2048x1536px.
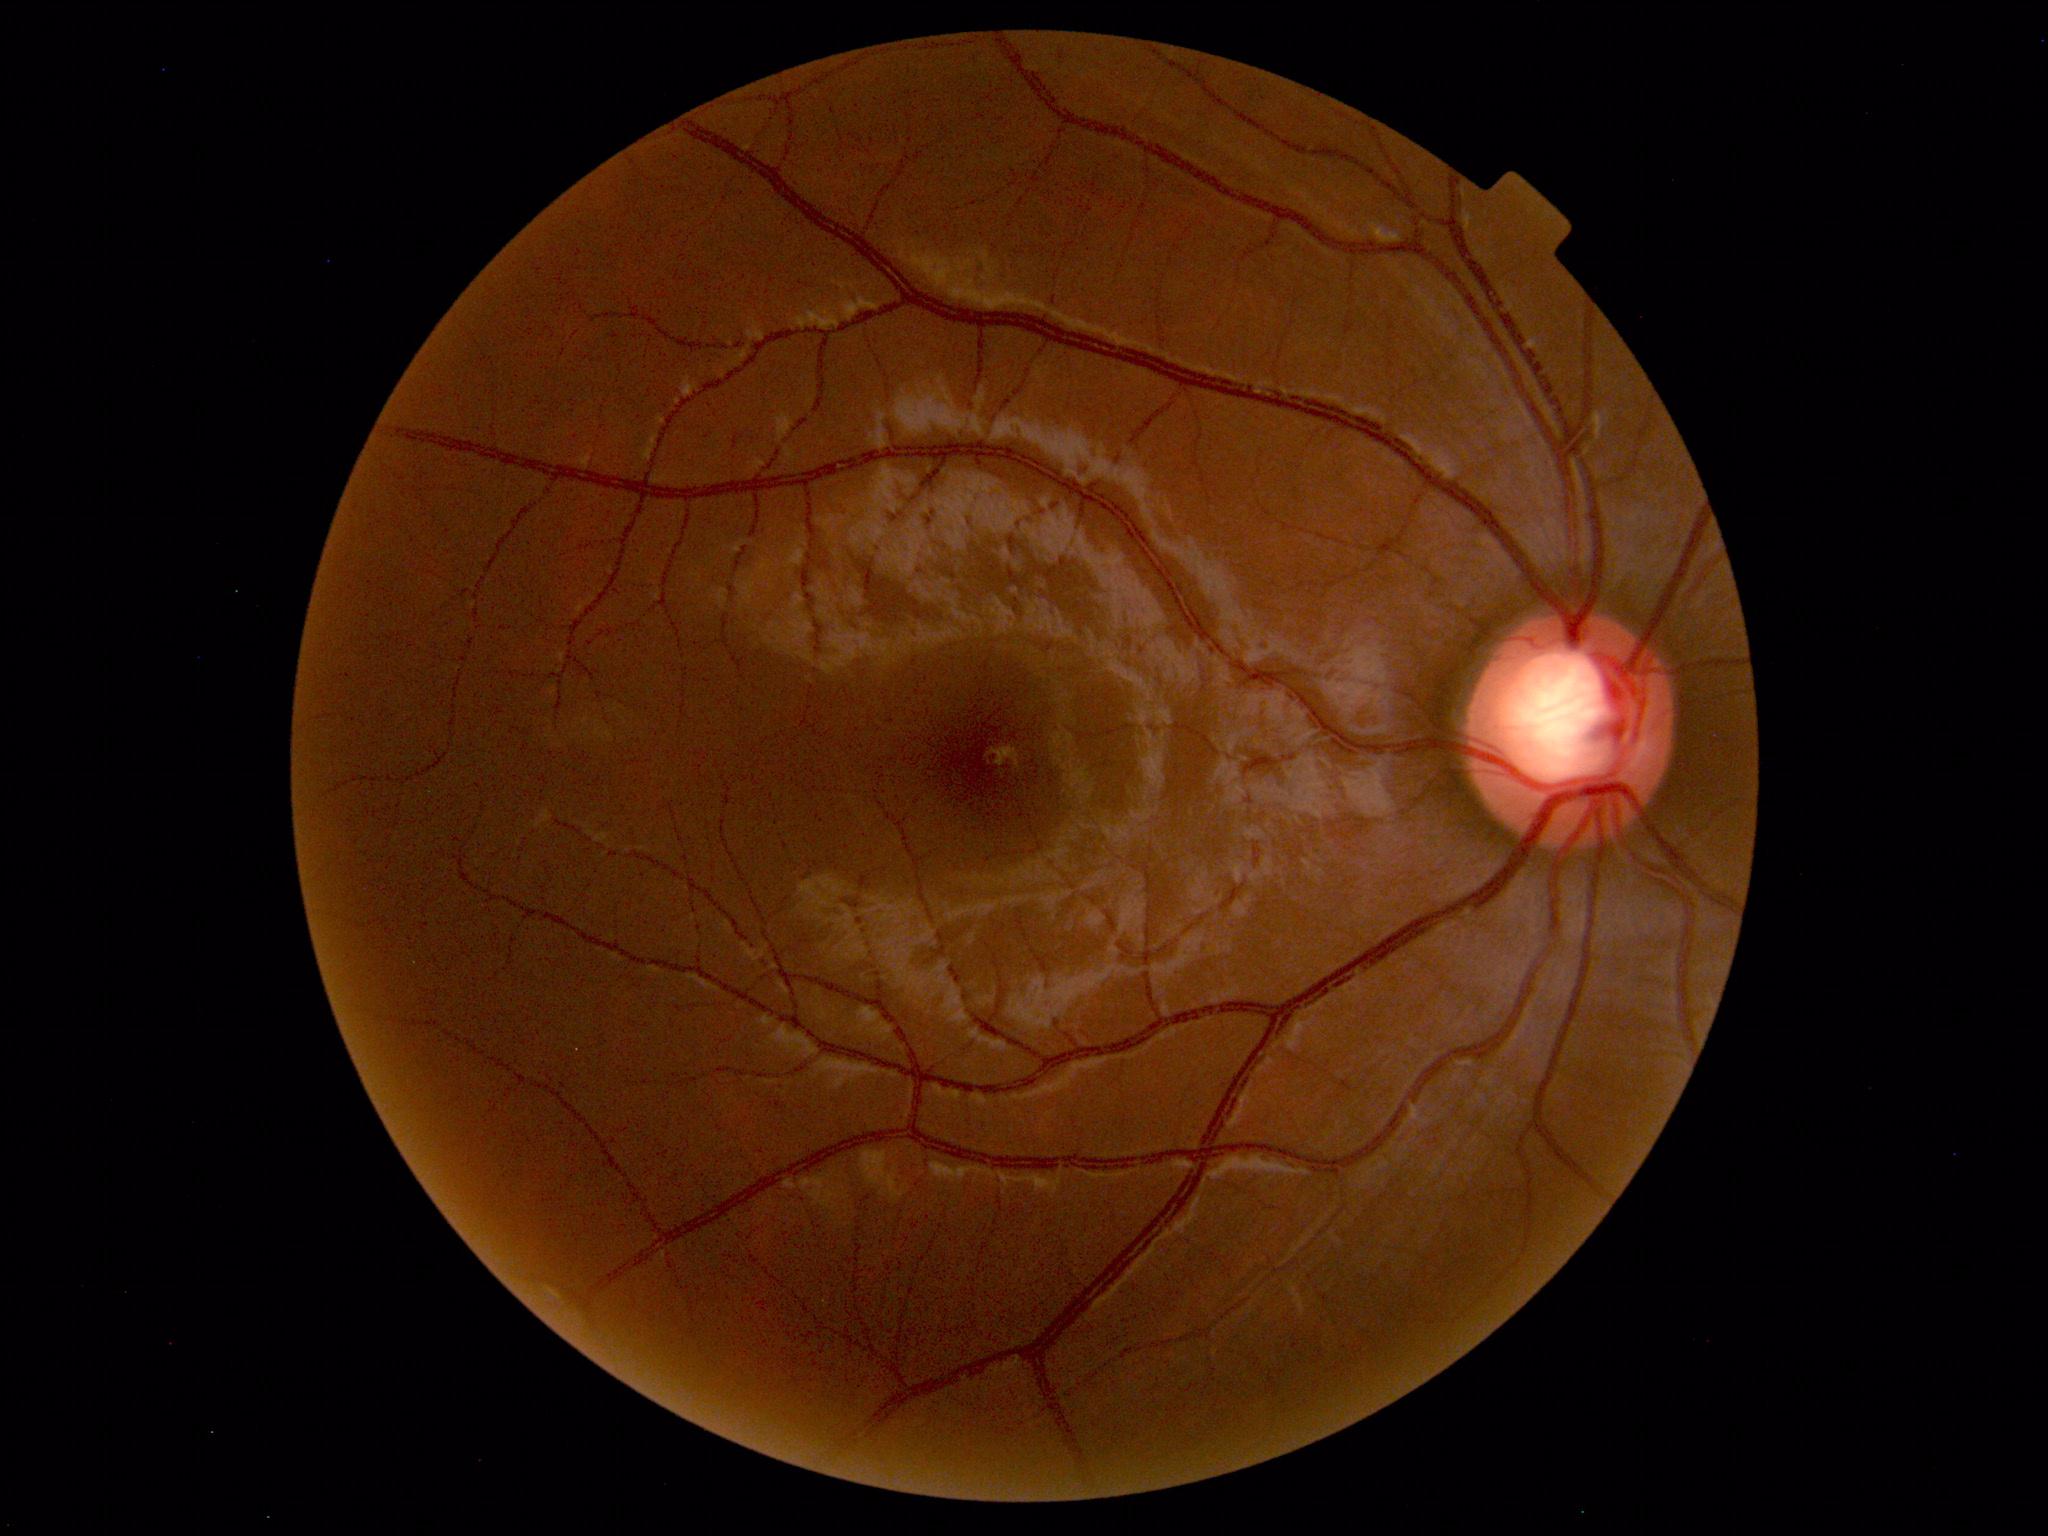

Normal color fundus photograph.